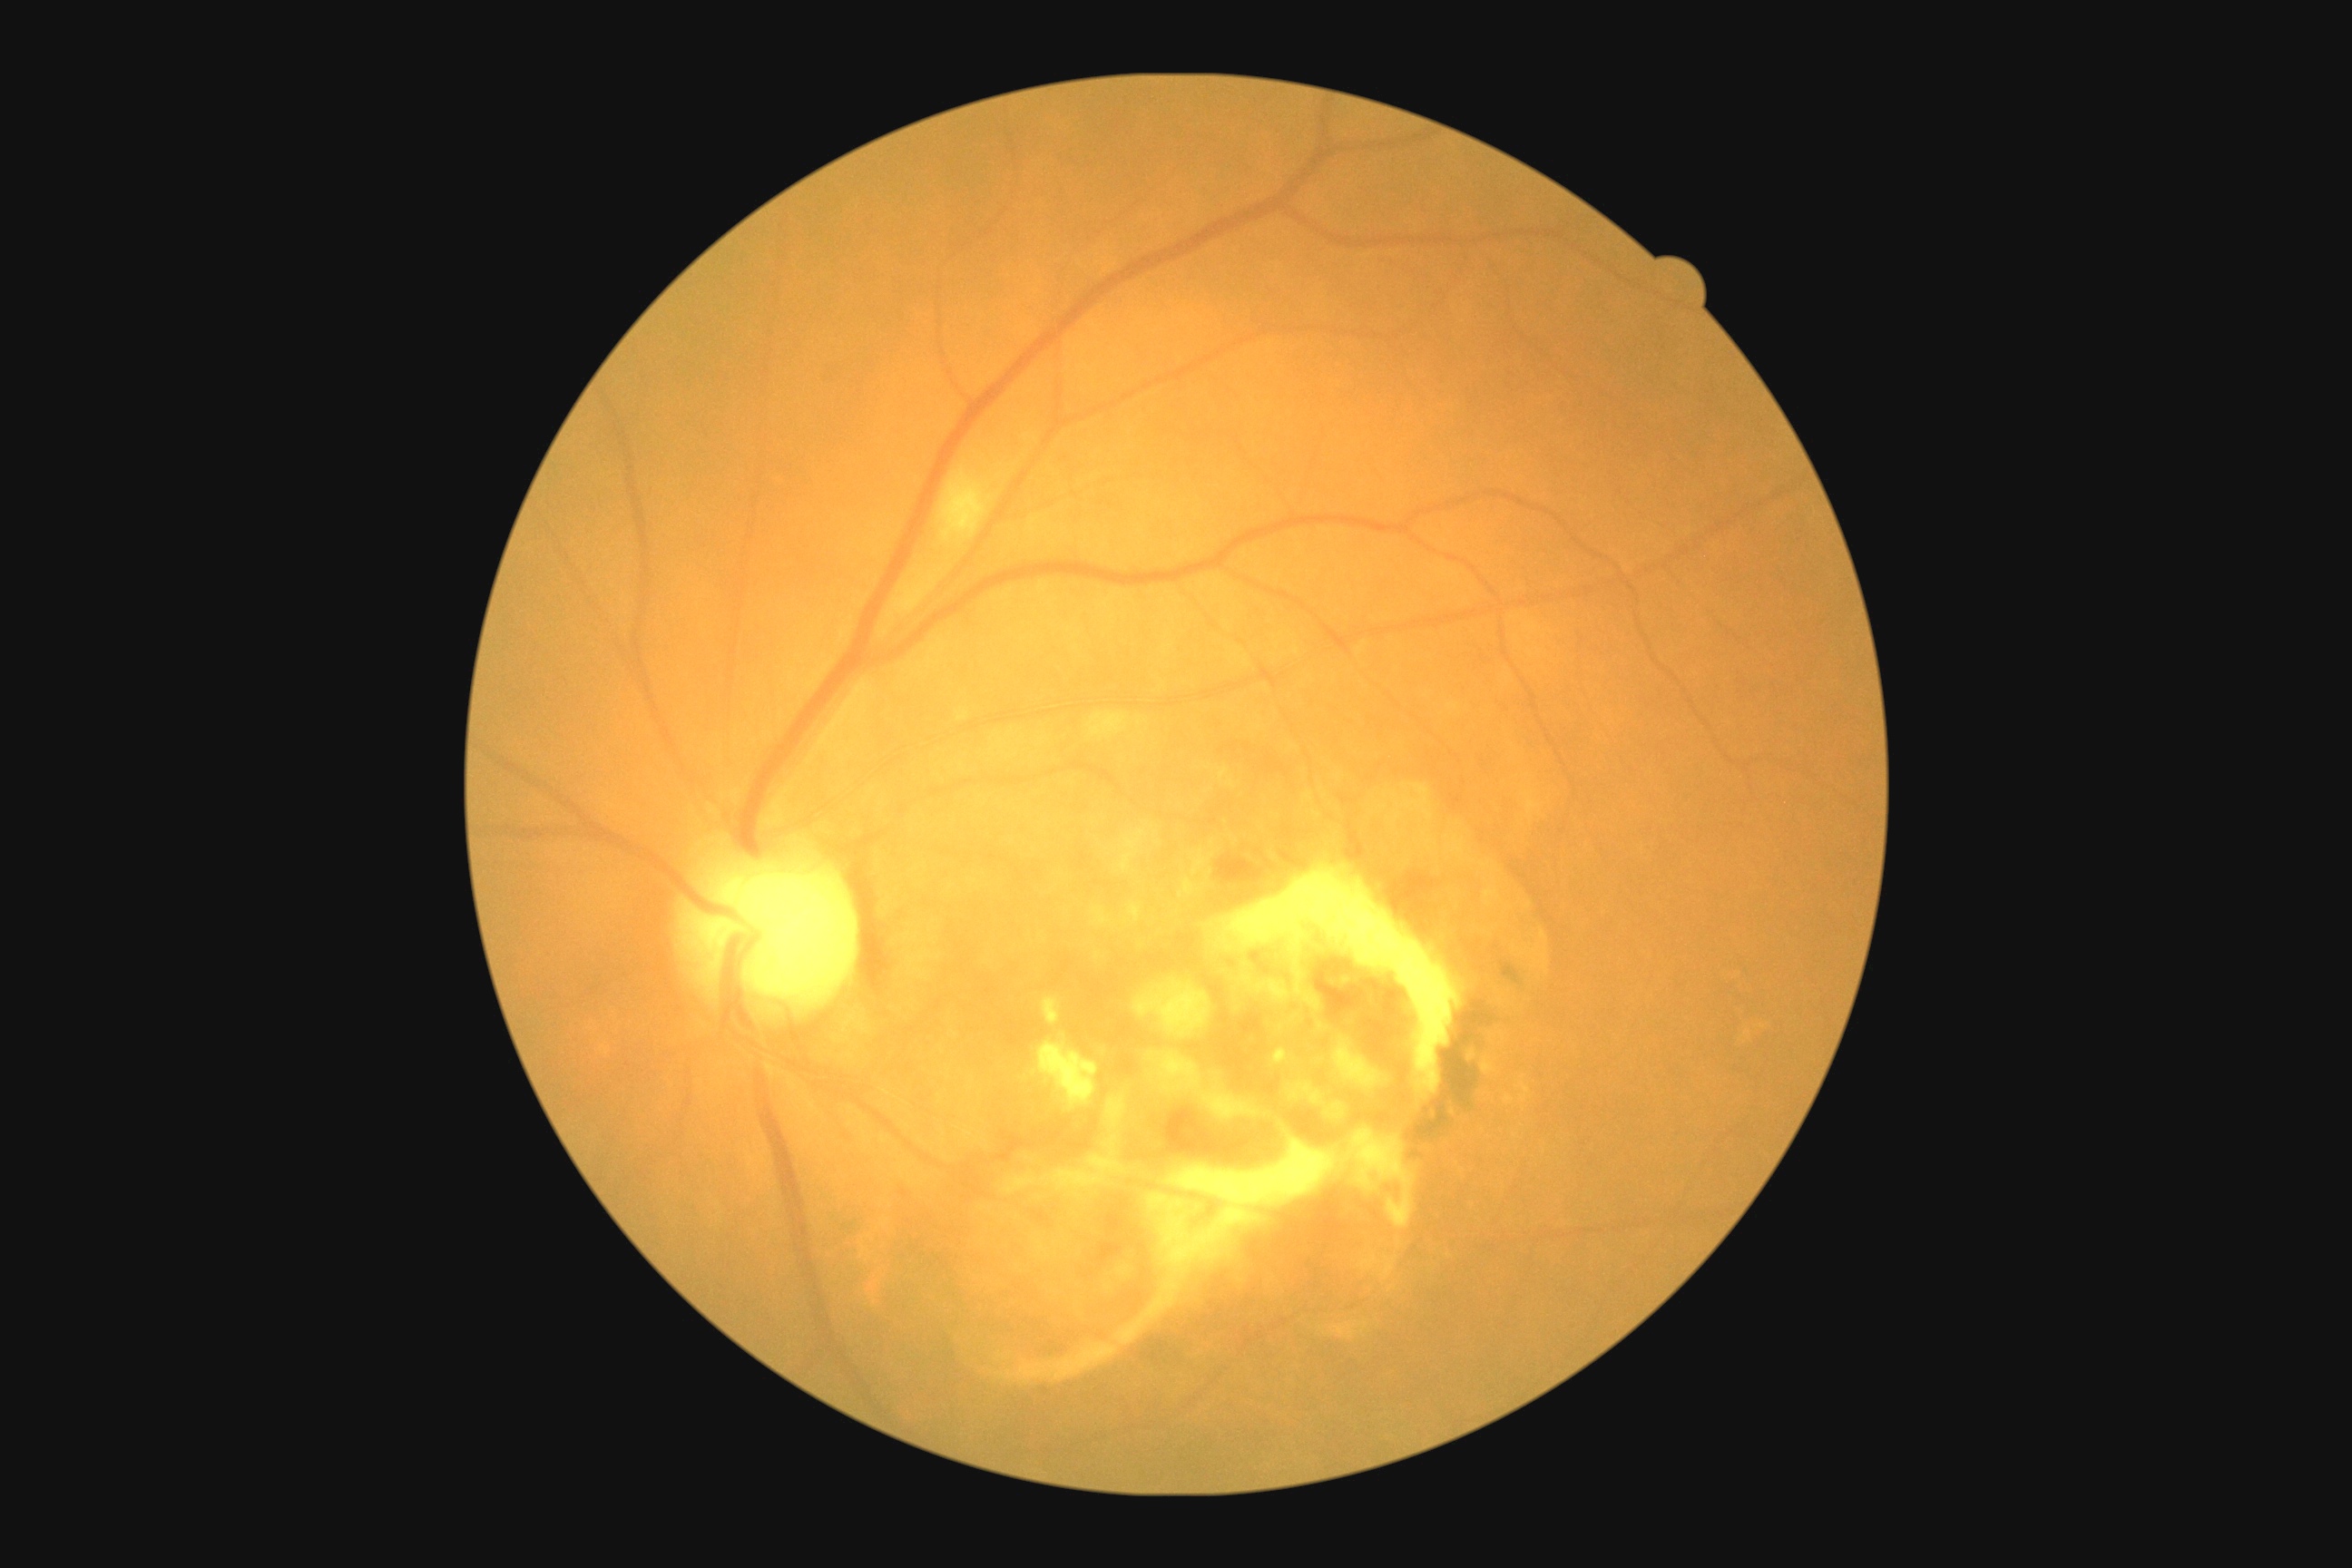
Diabetic retinopathy: grade 2 — more than just microaneurysms but less than severe NPDR.